Diabetic retinopathy graded by the modified Davis classification — 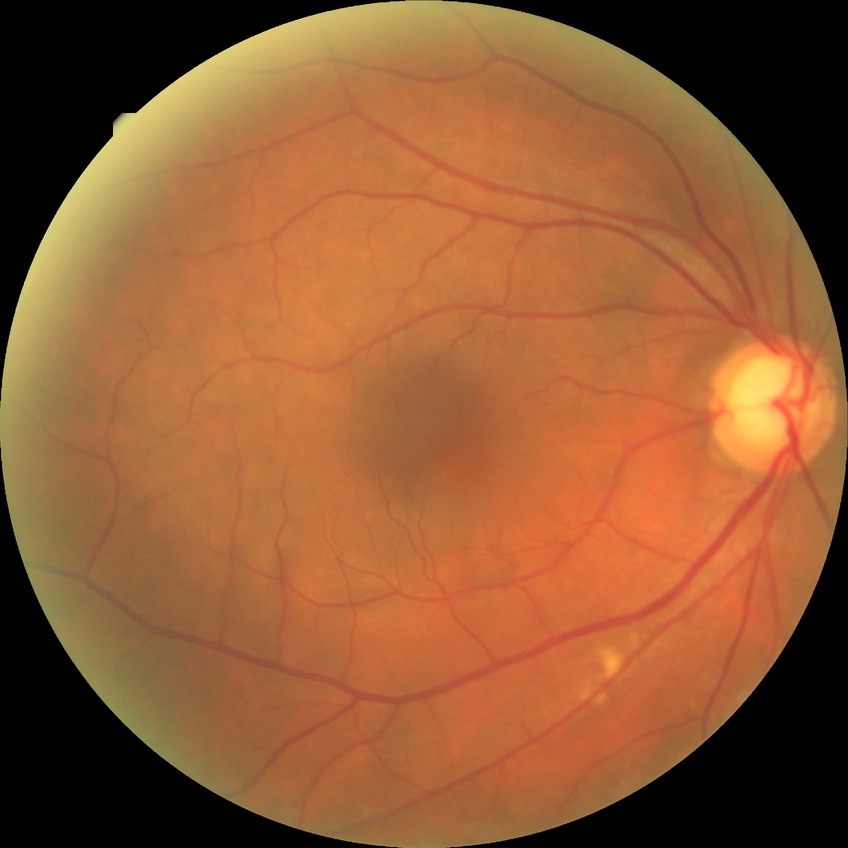 diabetic retinopathy (DR) = no diabetic retinopathy (NDR).